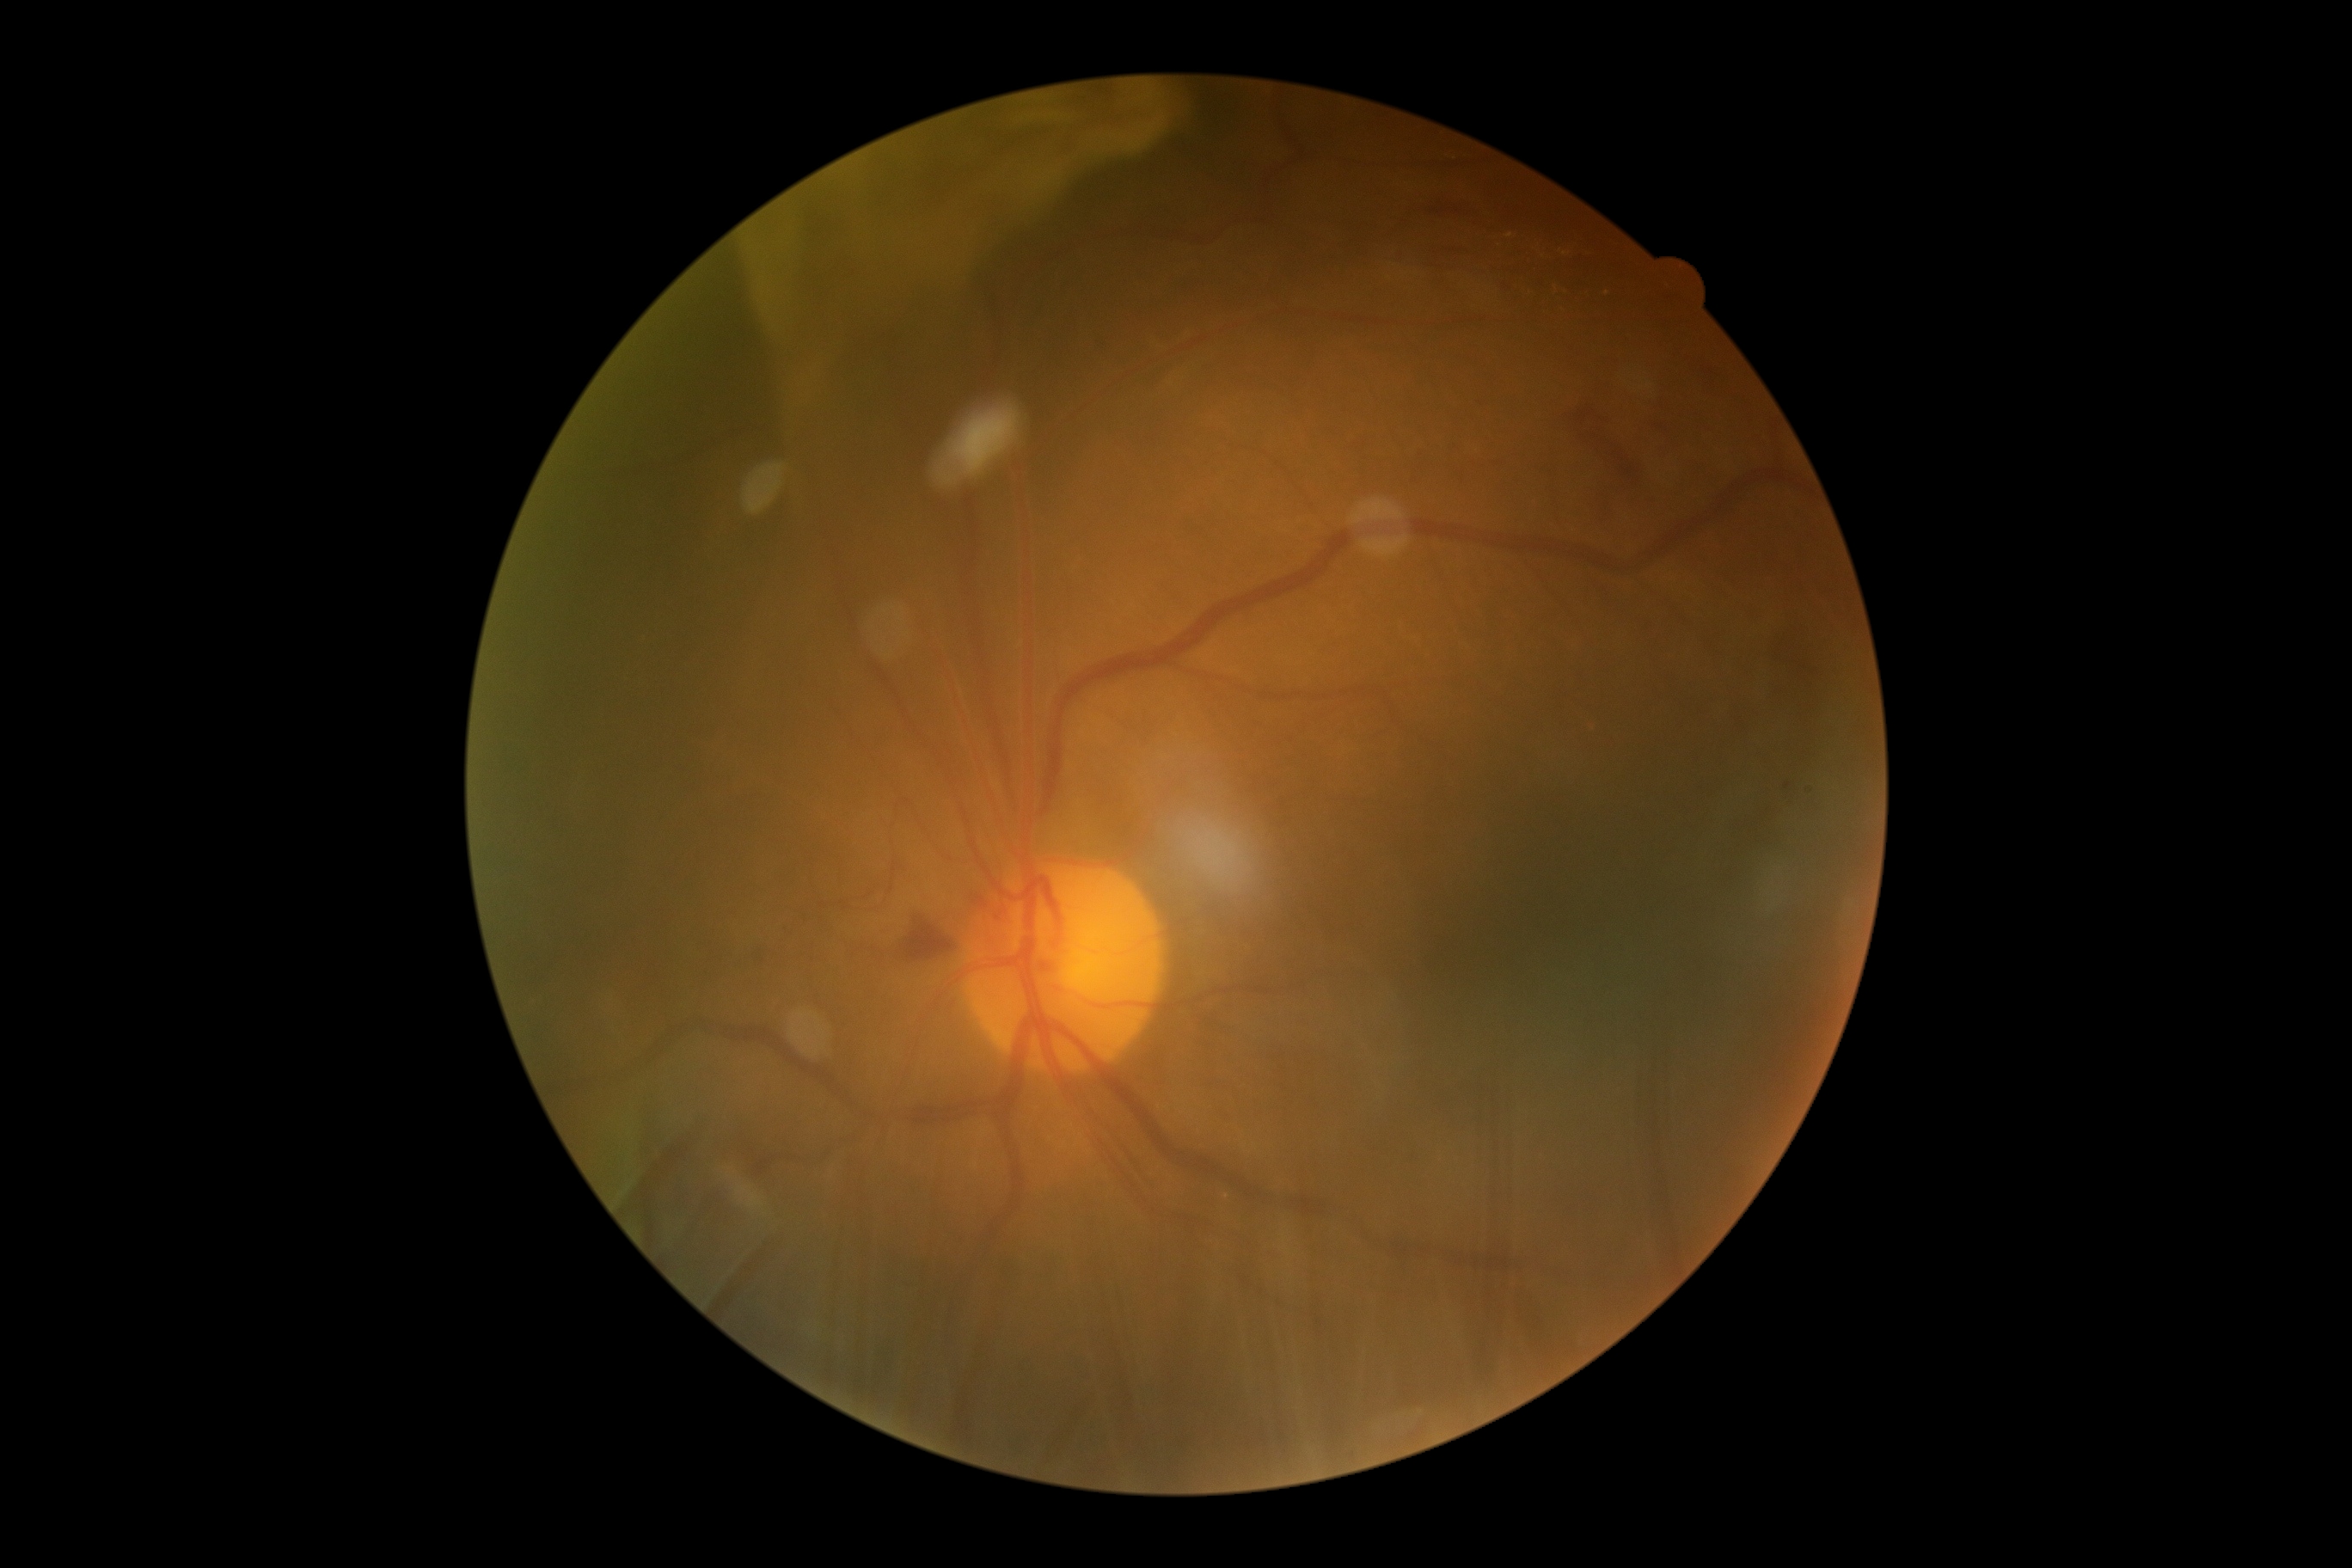

DR severity: grade 4 (PDR) — neovascularization and/or vitreous/pre-retinal hemorrhage.